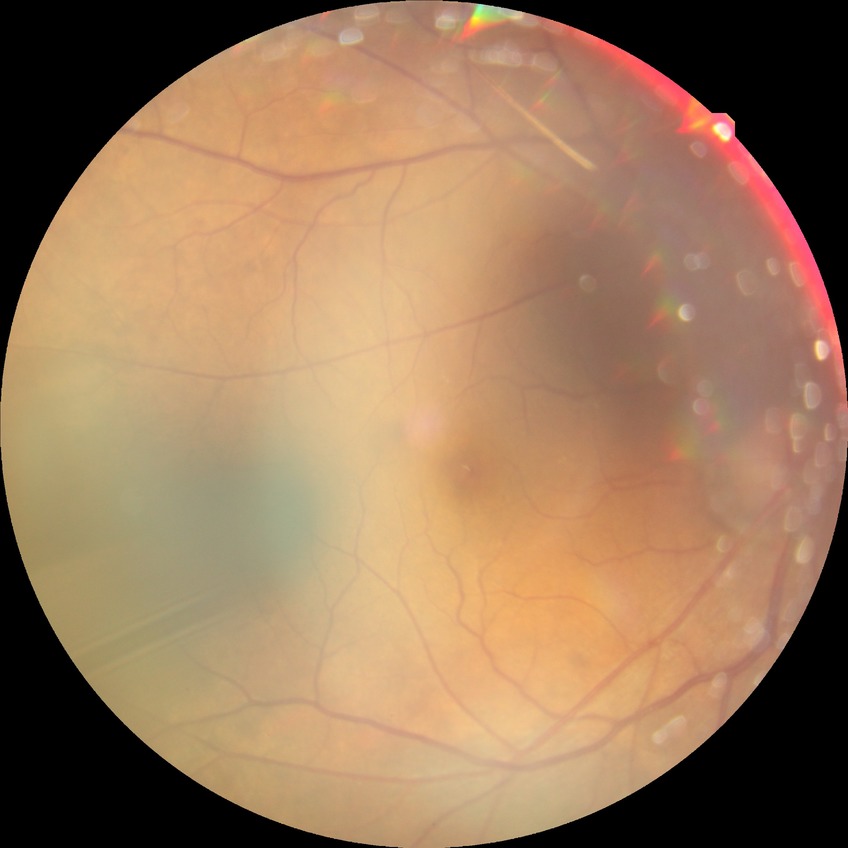 retinopathy grade@no diabetic retinopathy.